45° FOV · color fundus photograph · 2352 x 1568 pixels.
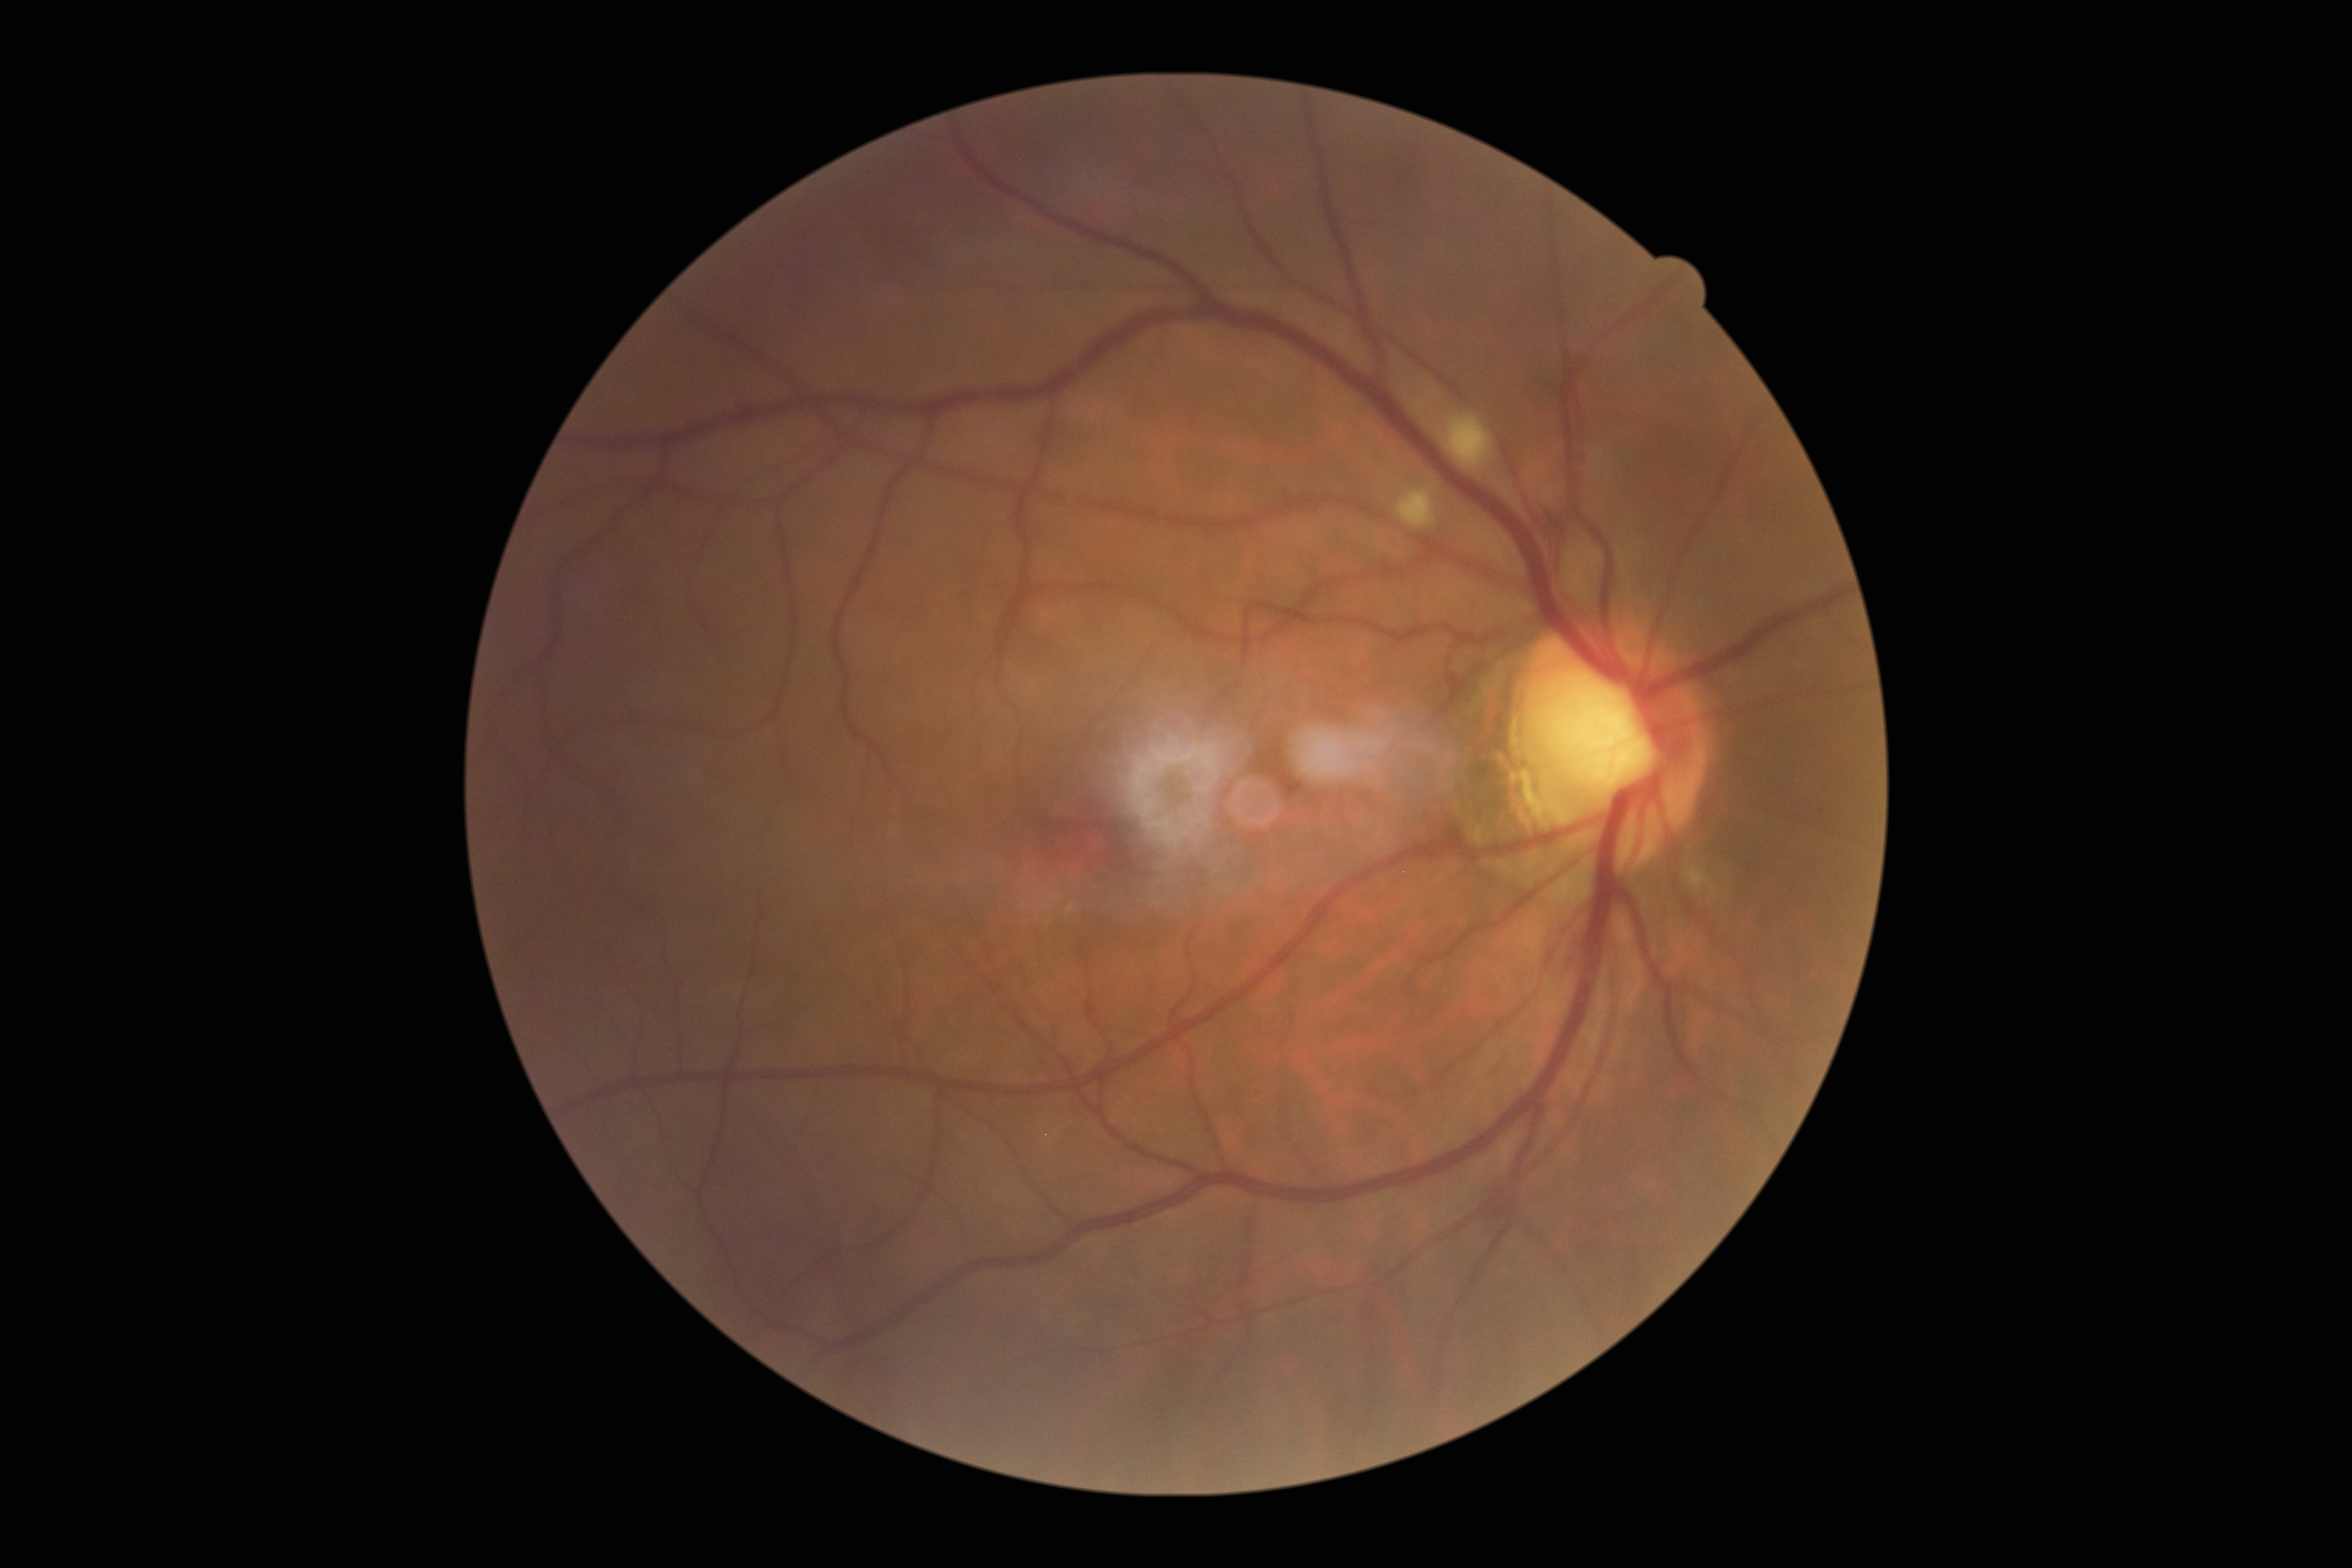
Diabetic retinopathy (DR) is 2.